Camera: Phoenix ICON (100° FOV) · wide-field fundus photograph of an infant · 1240 by 1240 pixels — 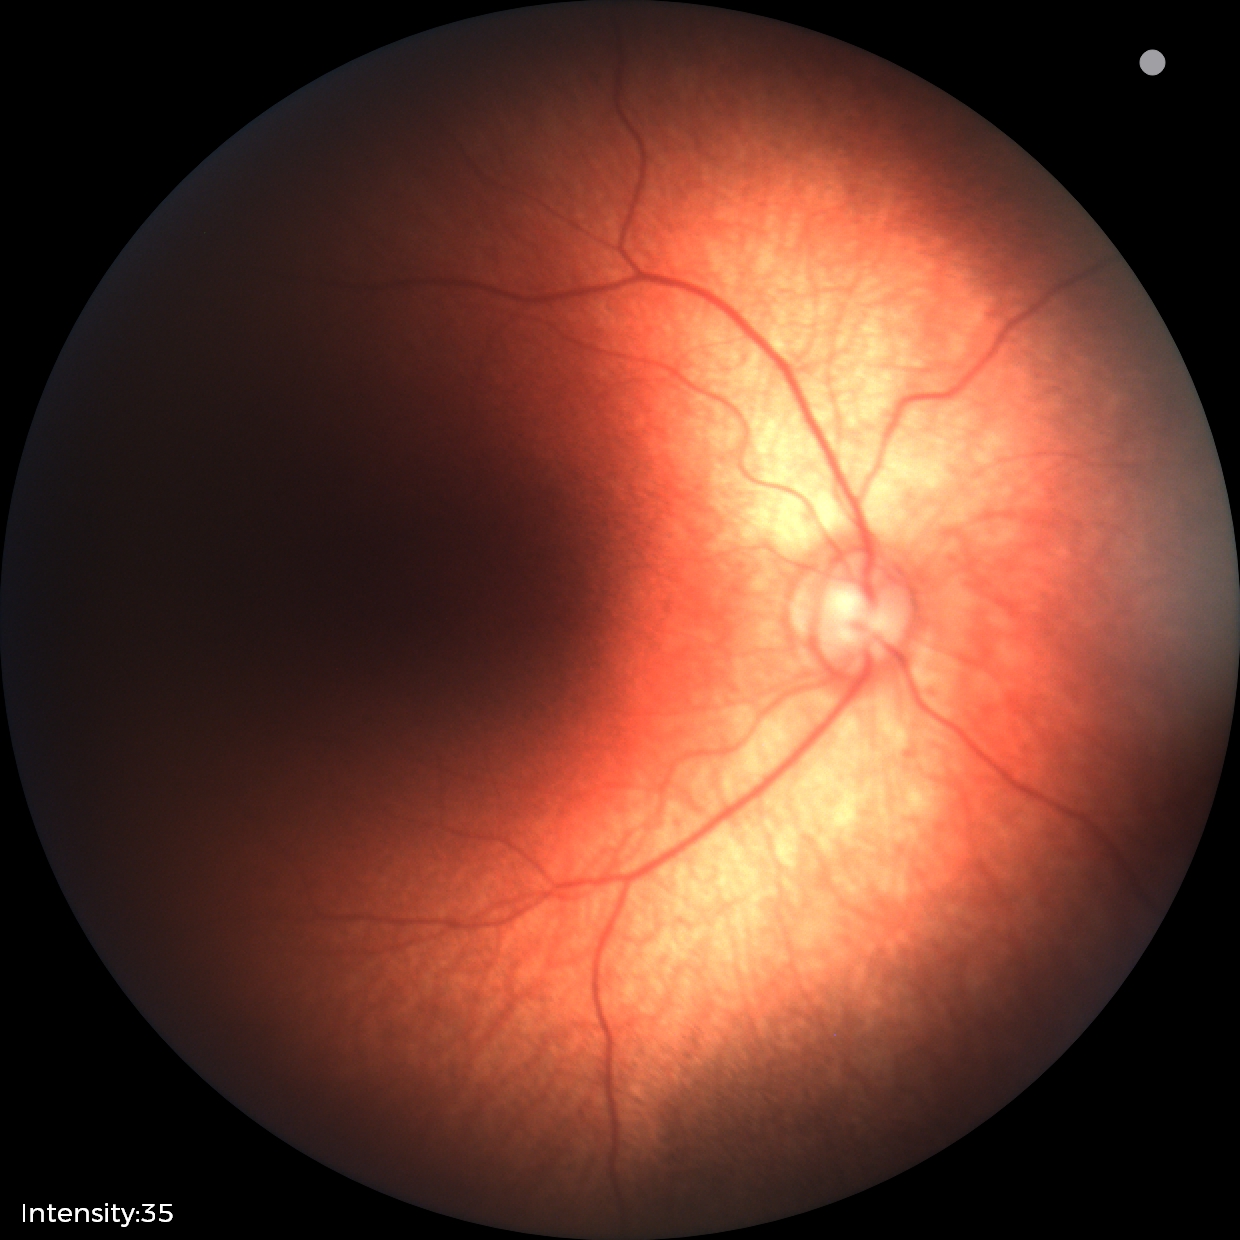
Physiological retinal appearance for postconceptual age.